Davis DR grading: 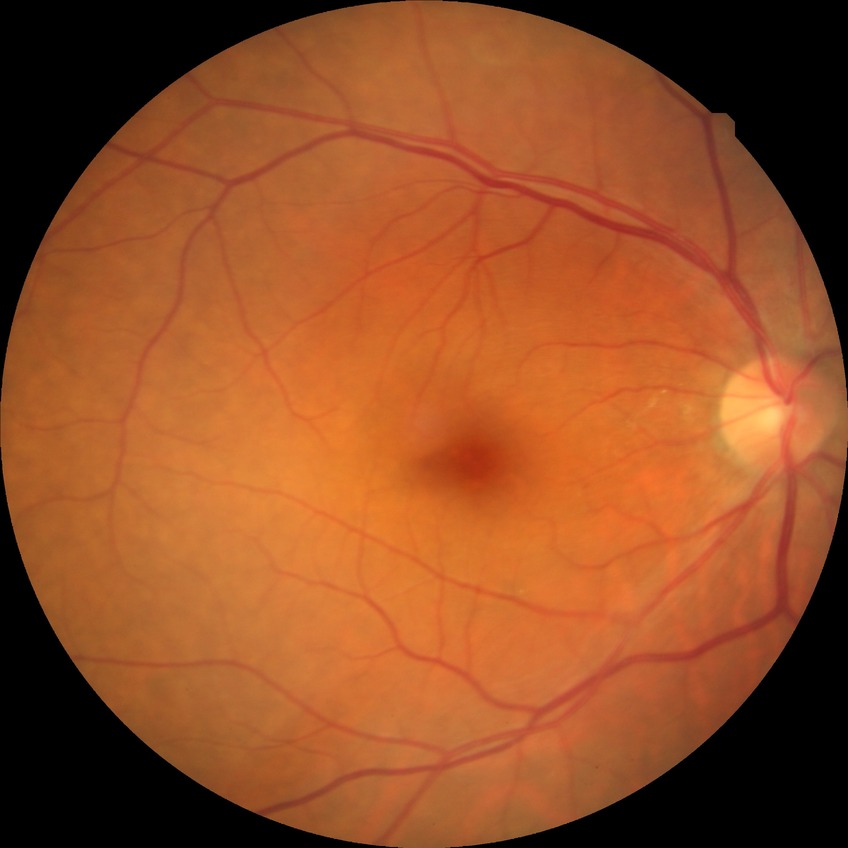

Diabetic retinopathy (DR): NDR (no diabetic retinopathy).